Image size 1240x1240; Phoenix ICON, 100° FOV; pediatric retinal photograph (wide-field): 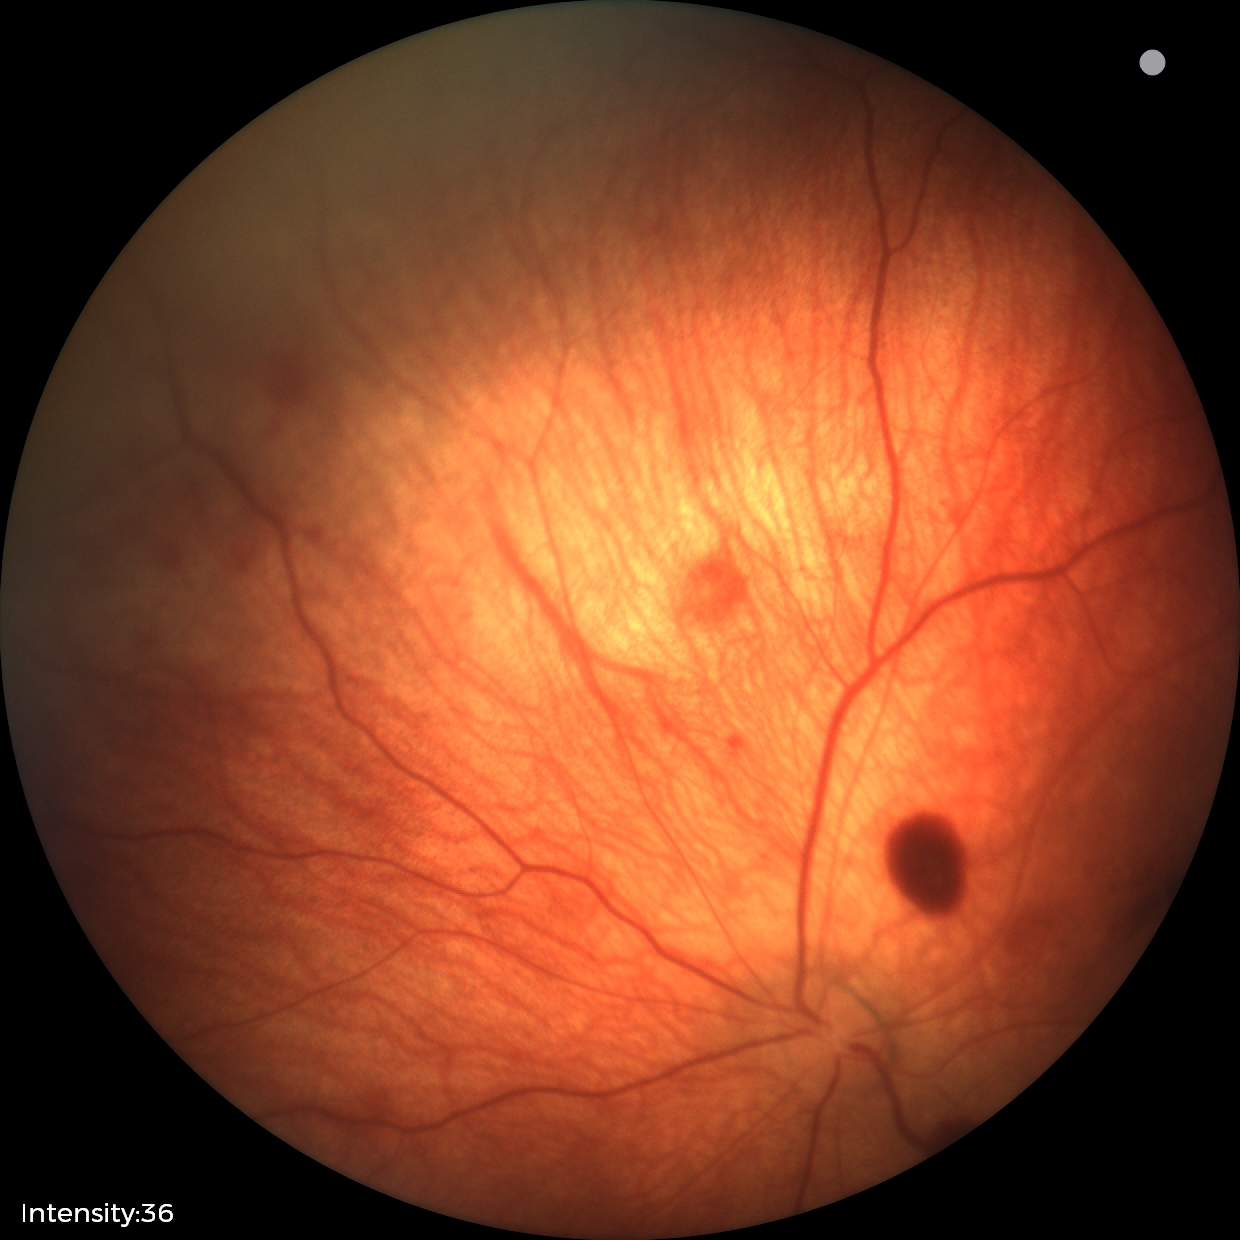

Screening examination consistent with retinal hemorrhages.